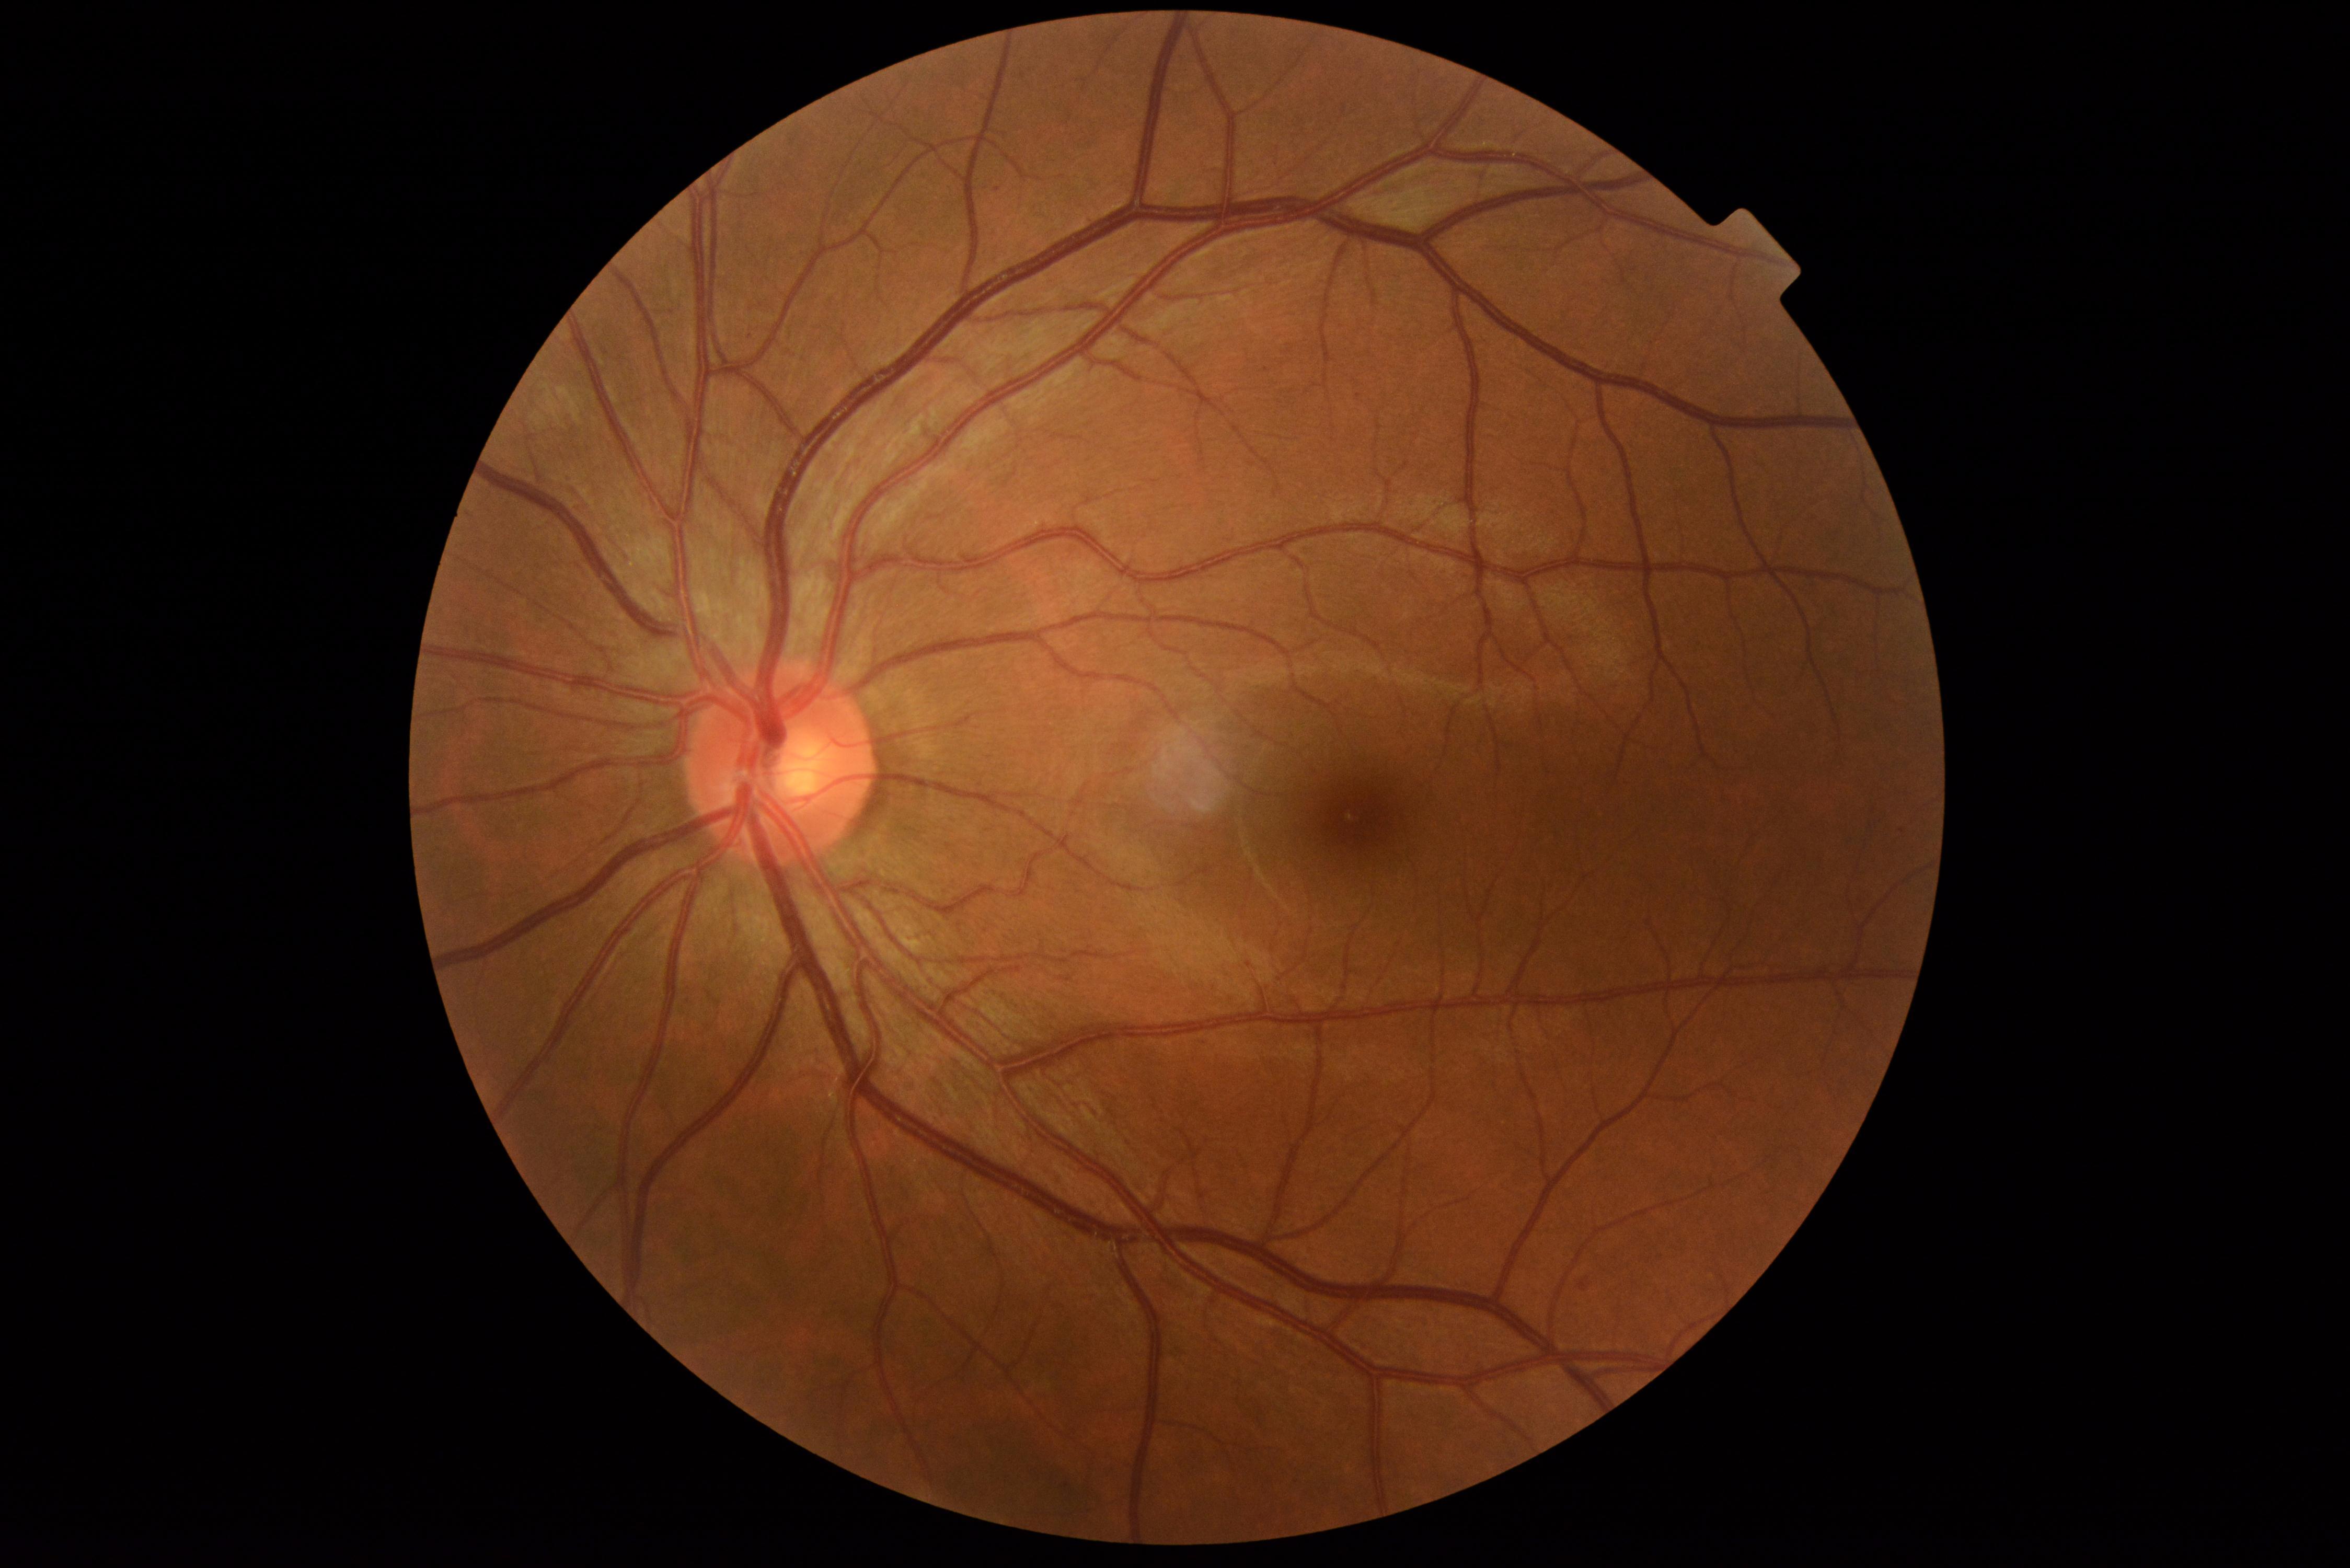
Diabetic retinopathy (DR) is grade 1 (mild NPDR).